2352x1568; FOV: 45 degrees; color fundus image.
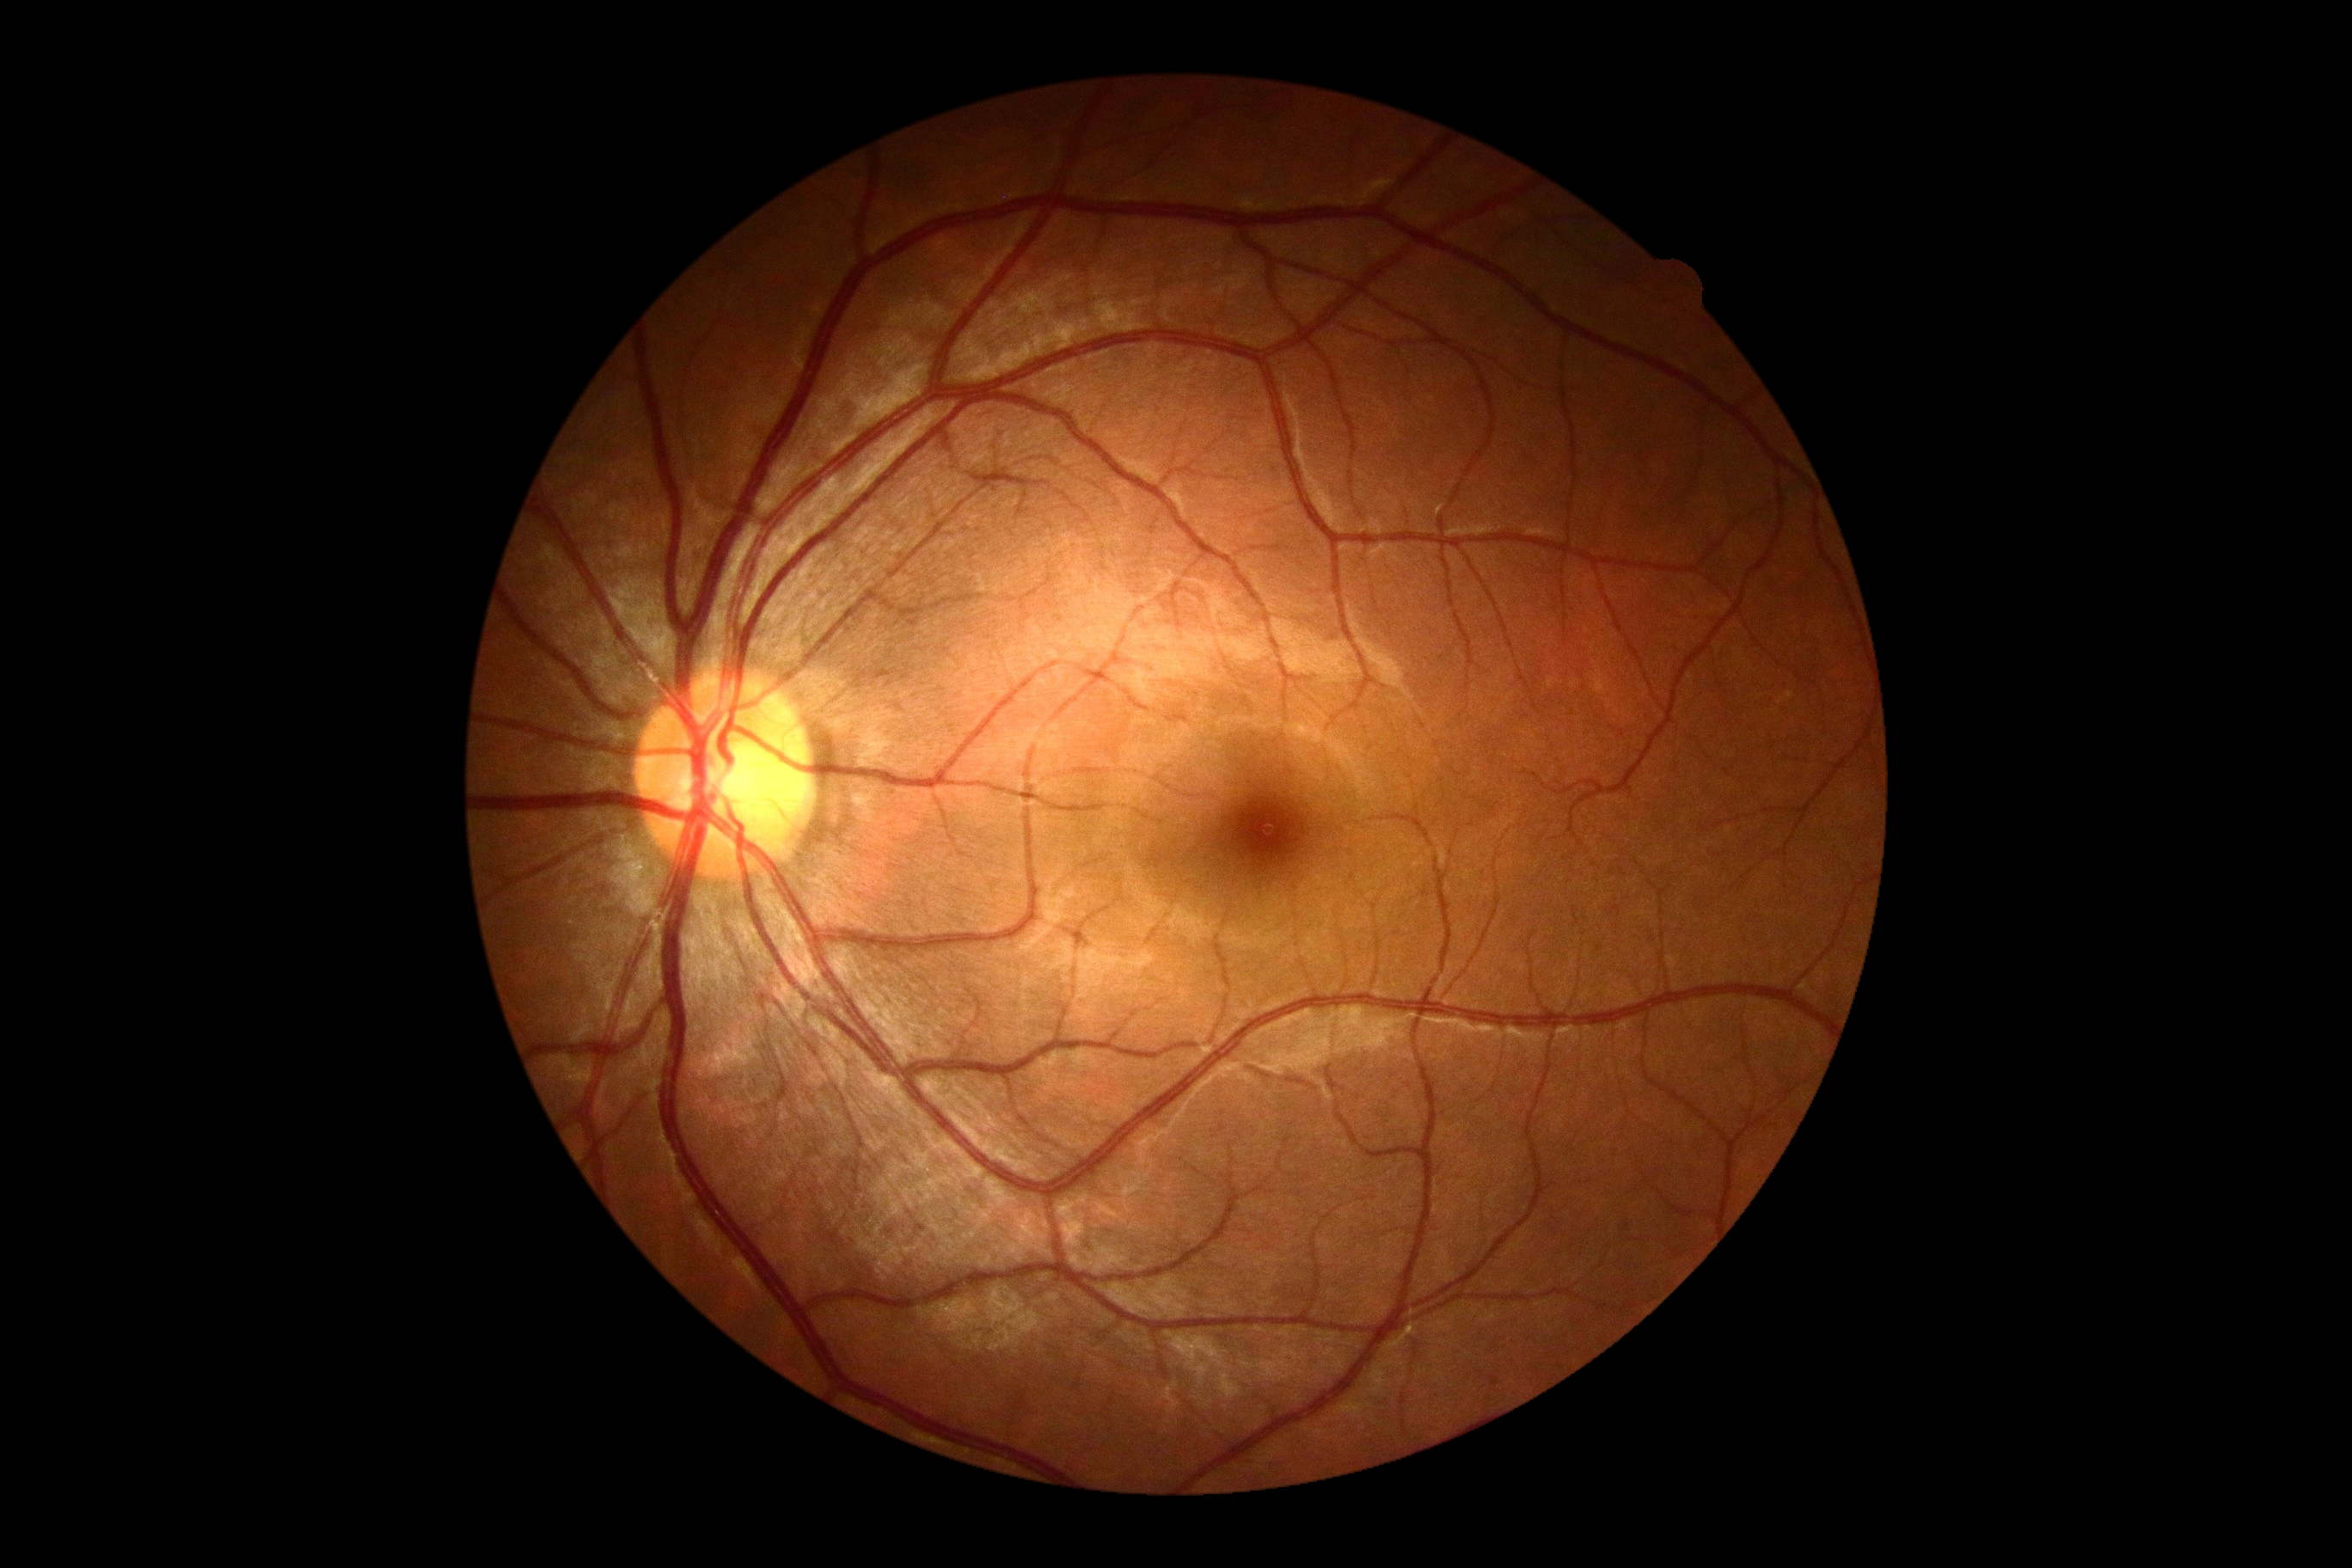
diabetic retinopathy (DR) = 0/4 — no visible signs of diabetic retinopathy.